Mydriatic, color fundus photograph centered on the optic disc, Topcon TRC fundus camera — 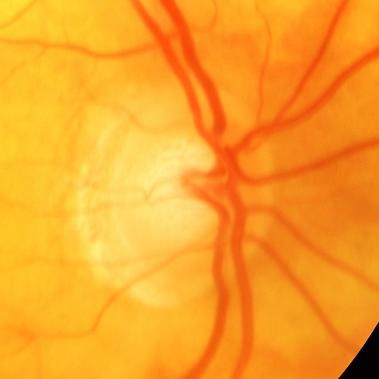 Demonstrates evidence of glaucoma.